45° field of view; image size 2352x1568
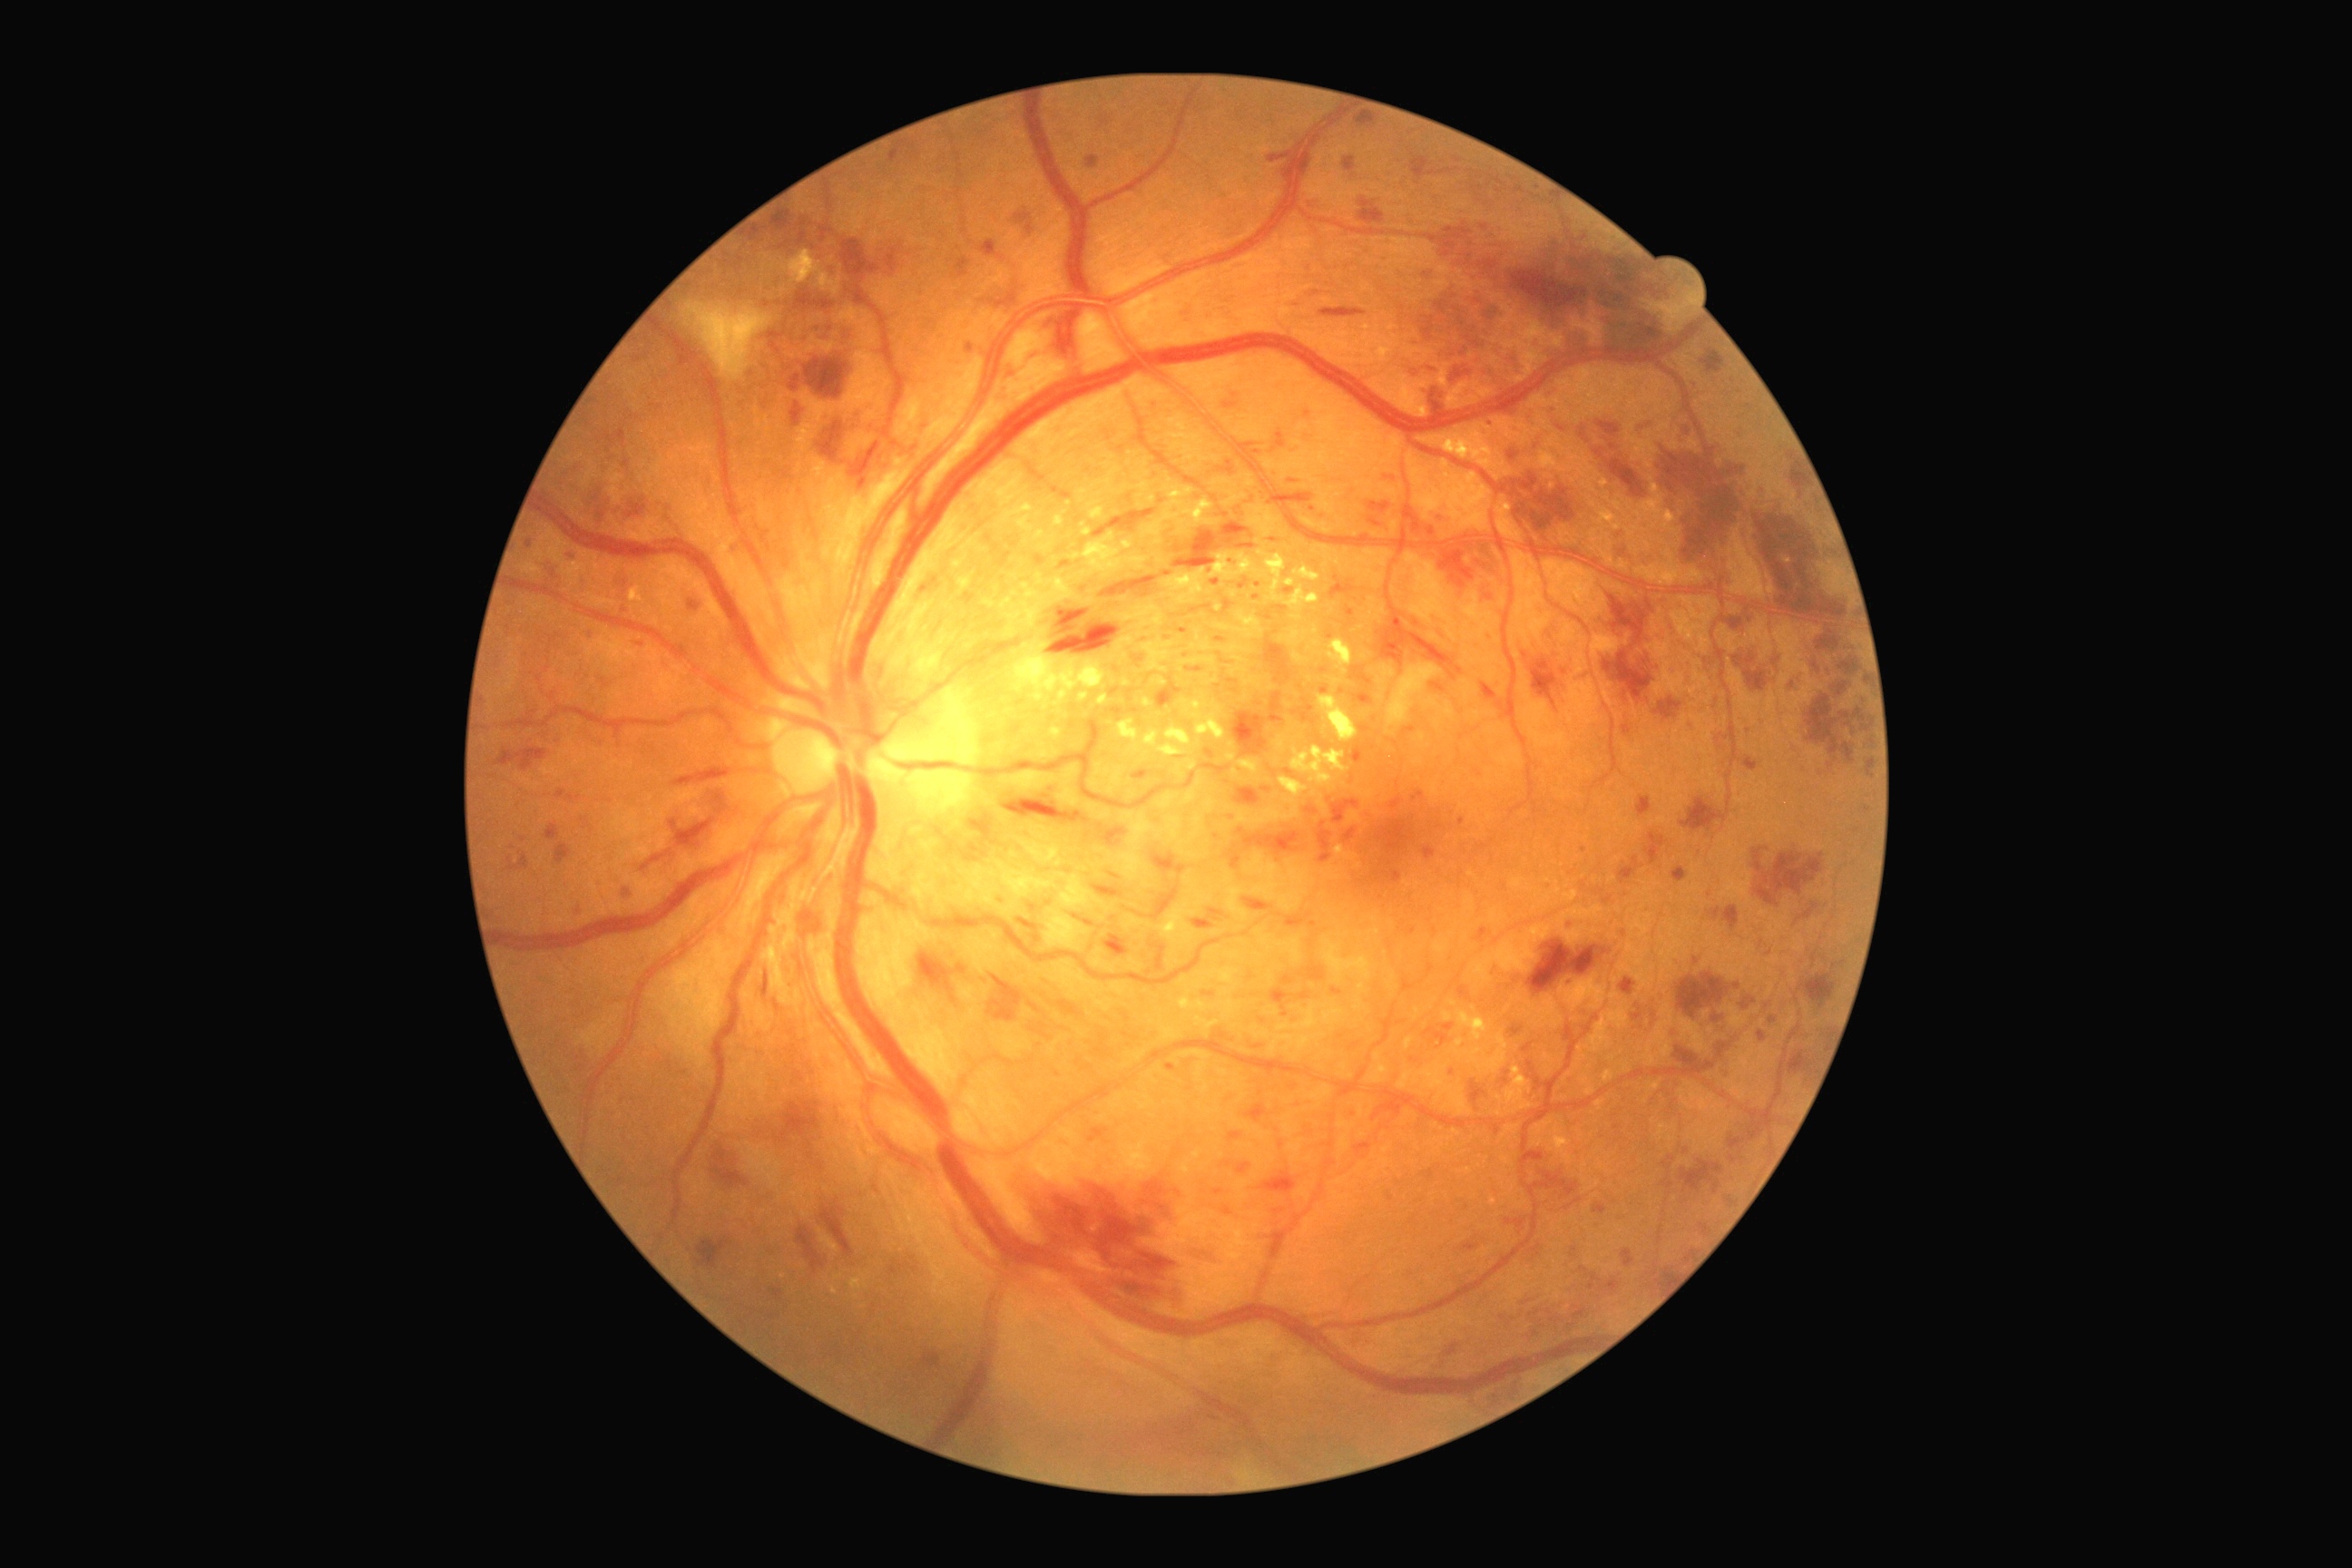 Diabetic retinopathy (DR): severe NPDR (grade 3).
Hard exudates (EXs) include those at (left=1220, top=645, right=1253, bottom=654); (left=1248, top=504, right=1284, bottom=538); (left=959, top=578, right=972, bottom=593); (left=1115, top=636, right=1133, bottom=663); (left=1318, top=696, right=1358, bottom=743); (left=1014, top=643, right=1106, bottom=710); (left=1313, top=627, right=1320, bottom=636); (left=1055, top=516, right=1064, bottom=525); (left=1291, top=614, right=1302, bottom=622); (left=1177, top=765, right=1186, bottom=779); (left=1456, top=1039, right=1464, bottom=1046); (left=1242, top=691, right=1251, bottom=701); (left=1458, top=1012, right=1489, bottom=1041); (left=1420, top=424, right=1505, bottom=471).
Small EXs approximately at 1209:592; 1161:562; 1314:793.
Hemorrhages (HEs) include those at (left=1104, top=934, right=1128, bottom=957); (left=798, top=1226, right=825, bottom=1273); (left=554, top=843, right=573, bottom=865); (left=1580, top=1268, right=1622, bottom=1295); (left=627, top=502, right=647, bottom=520); (left=1741, top=756, right=1759, bottom=770); (left=1663, top=1269, right=1672, bottom=1280); (left=1638, top=796, right=1652, bottom=818); (left=805, top=358, right=848, bottom=400); (left=1507, top=449, right=1520, bottom=460); (left=1522, top=1291, right=1547, bottom=1309); (left=1524, top=1309, right=1562, bottom=1328); (left=1358, top=197, right=1386, bottom=226); (left=1507, top=475, right=1583, bottom=536); (left=1411, top=220, right=1671, bottom=389); (left=707, top=1139, right=756, bottom=1197); (left=1527, top=1170, right=1580, bottom=1200).
Small HEs approximately at 1460:671; 1831:766.
Soft exudates (SEs) are located at (left=1378, top=665, right=1396, bottom=685); (left=1044, top=908, right=1090, bottom=952); (left=997, top=861, right=1104, bottom=910); (left=683, top=302, right=774, bottom=382); (left=1387, top=663, right=1442, bottom=727).
Small SEs approximately at 1382:698; 1387:732.
Microaneurysms (MAs) include those at (left=888, top=142, right=916, bottom=164); (left=1286, top=914, right=1313, bottom=926); (left=625, top=890, right=631, bottom=903); (left=1712, top=1015, right=1725, bottom=1023); (left=858, top=478, right=868, bottom=489); (left=1308, top=968, right=1326, bottom=981); (left=821, top=226, right=830, bottom=242); (left=1487, top=634, right=1493, bottom=643); (left=1551, top=407, right=1560, bottom=415); (left=1034, top=934, right=1041, bottom=945); (left=1582, top=429, right=1585, bottom=438); (left=587, top=631, right=596, bottom=642); (left=963, top=593, right=977, bottom=605); (left=1090, top=1128, right=1108, bottom=1142).
Small MAs approximately at 1687:1150; 1569:986; 1330:637; 1033:908; 1365:729.